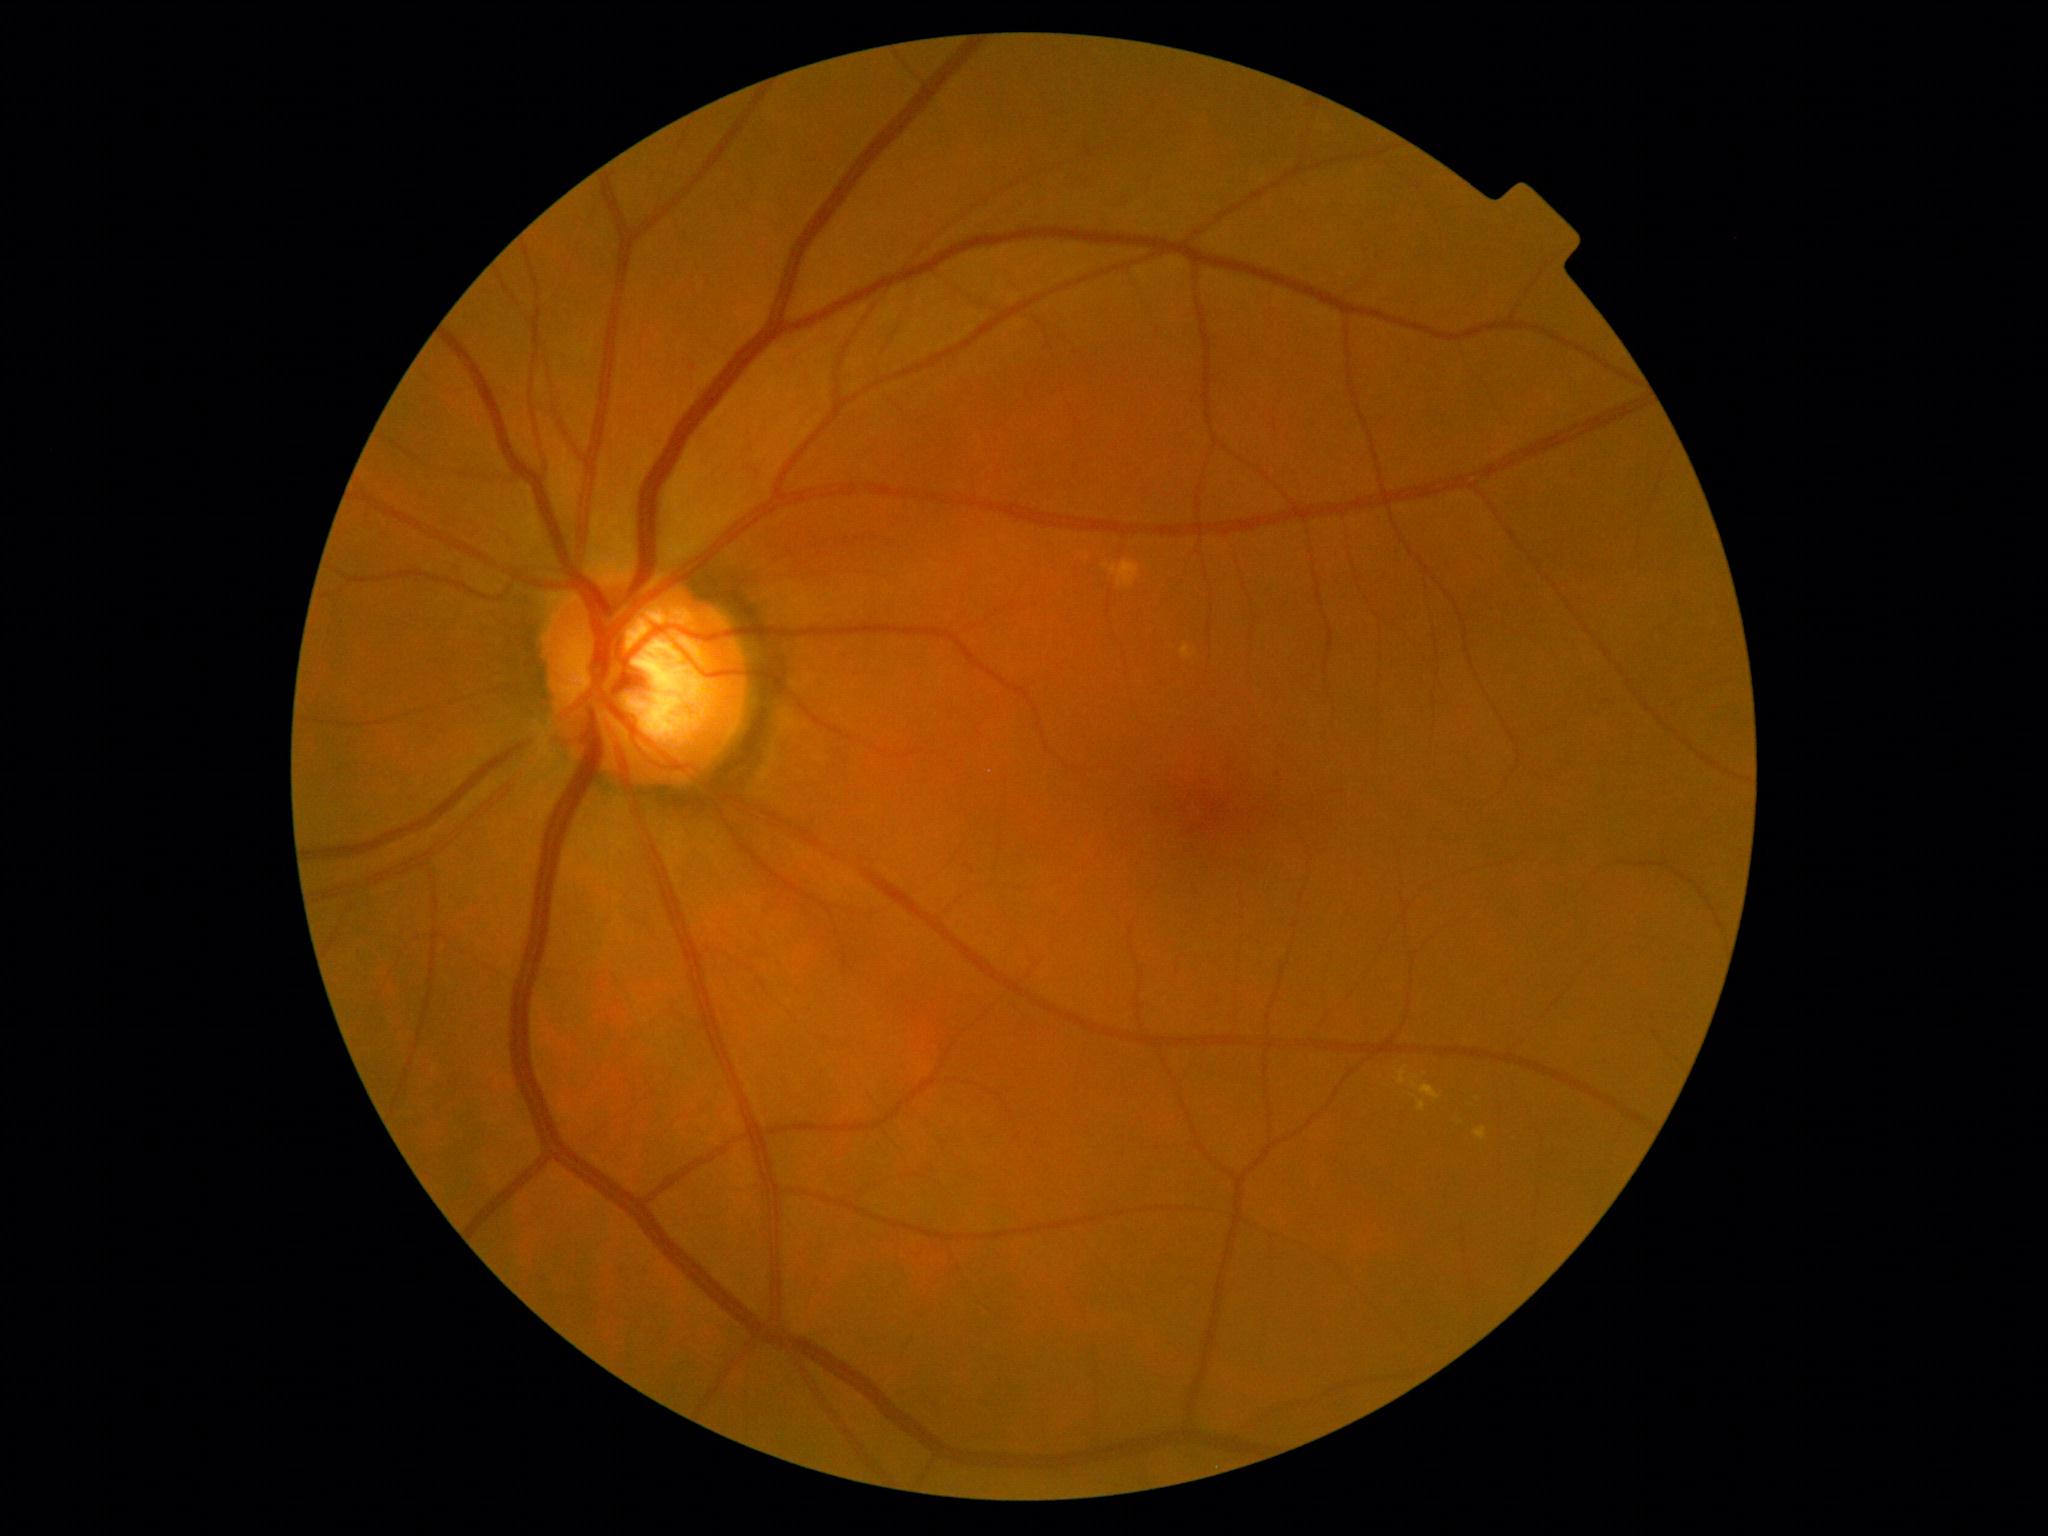 Diabetic retinopathy (DR): 2. The retinopathy is classified as non-proliferative diabetic retinopathy.